640 x 480 pixels · infant wide-field fundus photograph: 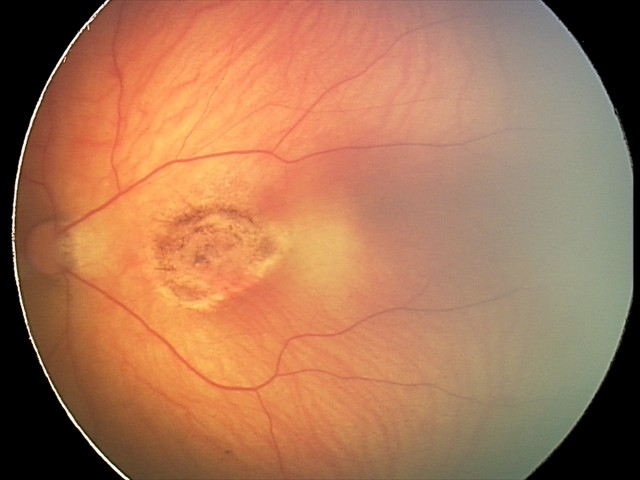

Diagnosis from this screening exam: toxoplasmosis chorioretinitis.